Color fundus image:
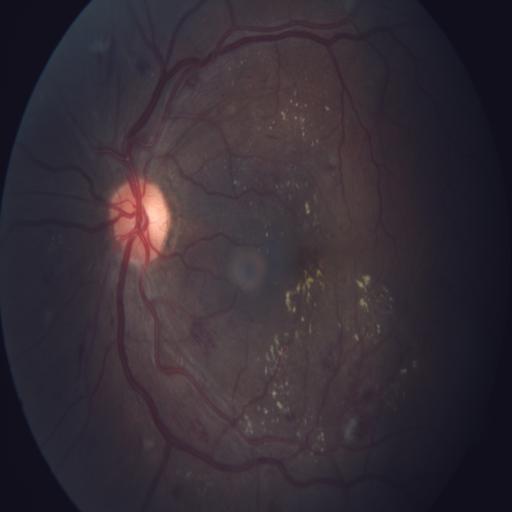

Three abnormalities. There is evidence of exudation, hemorrhagic retinopathy, and media haze.